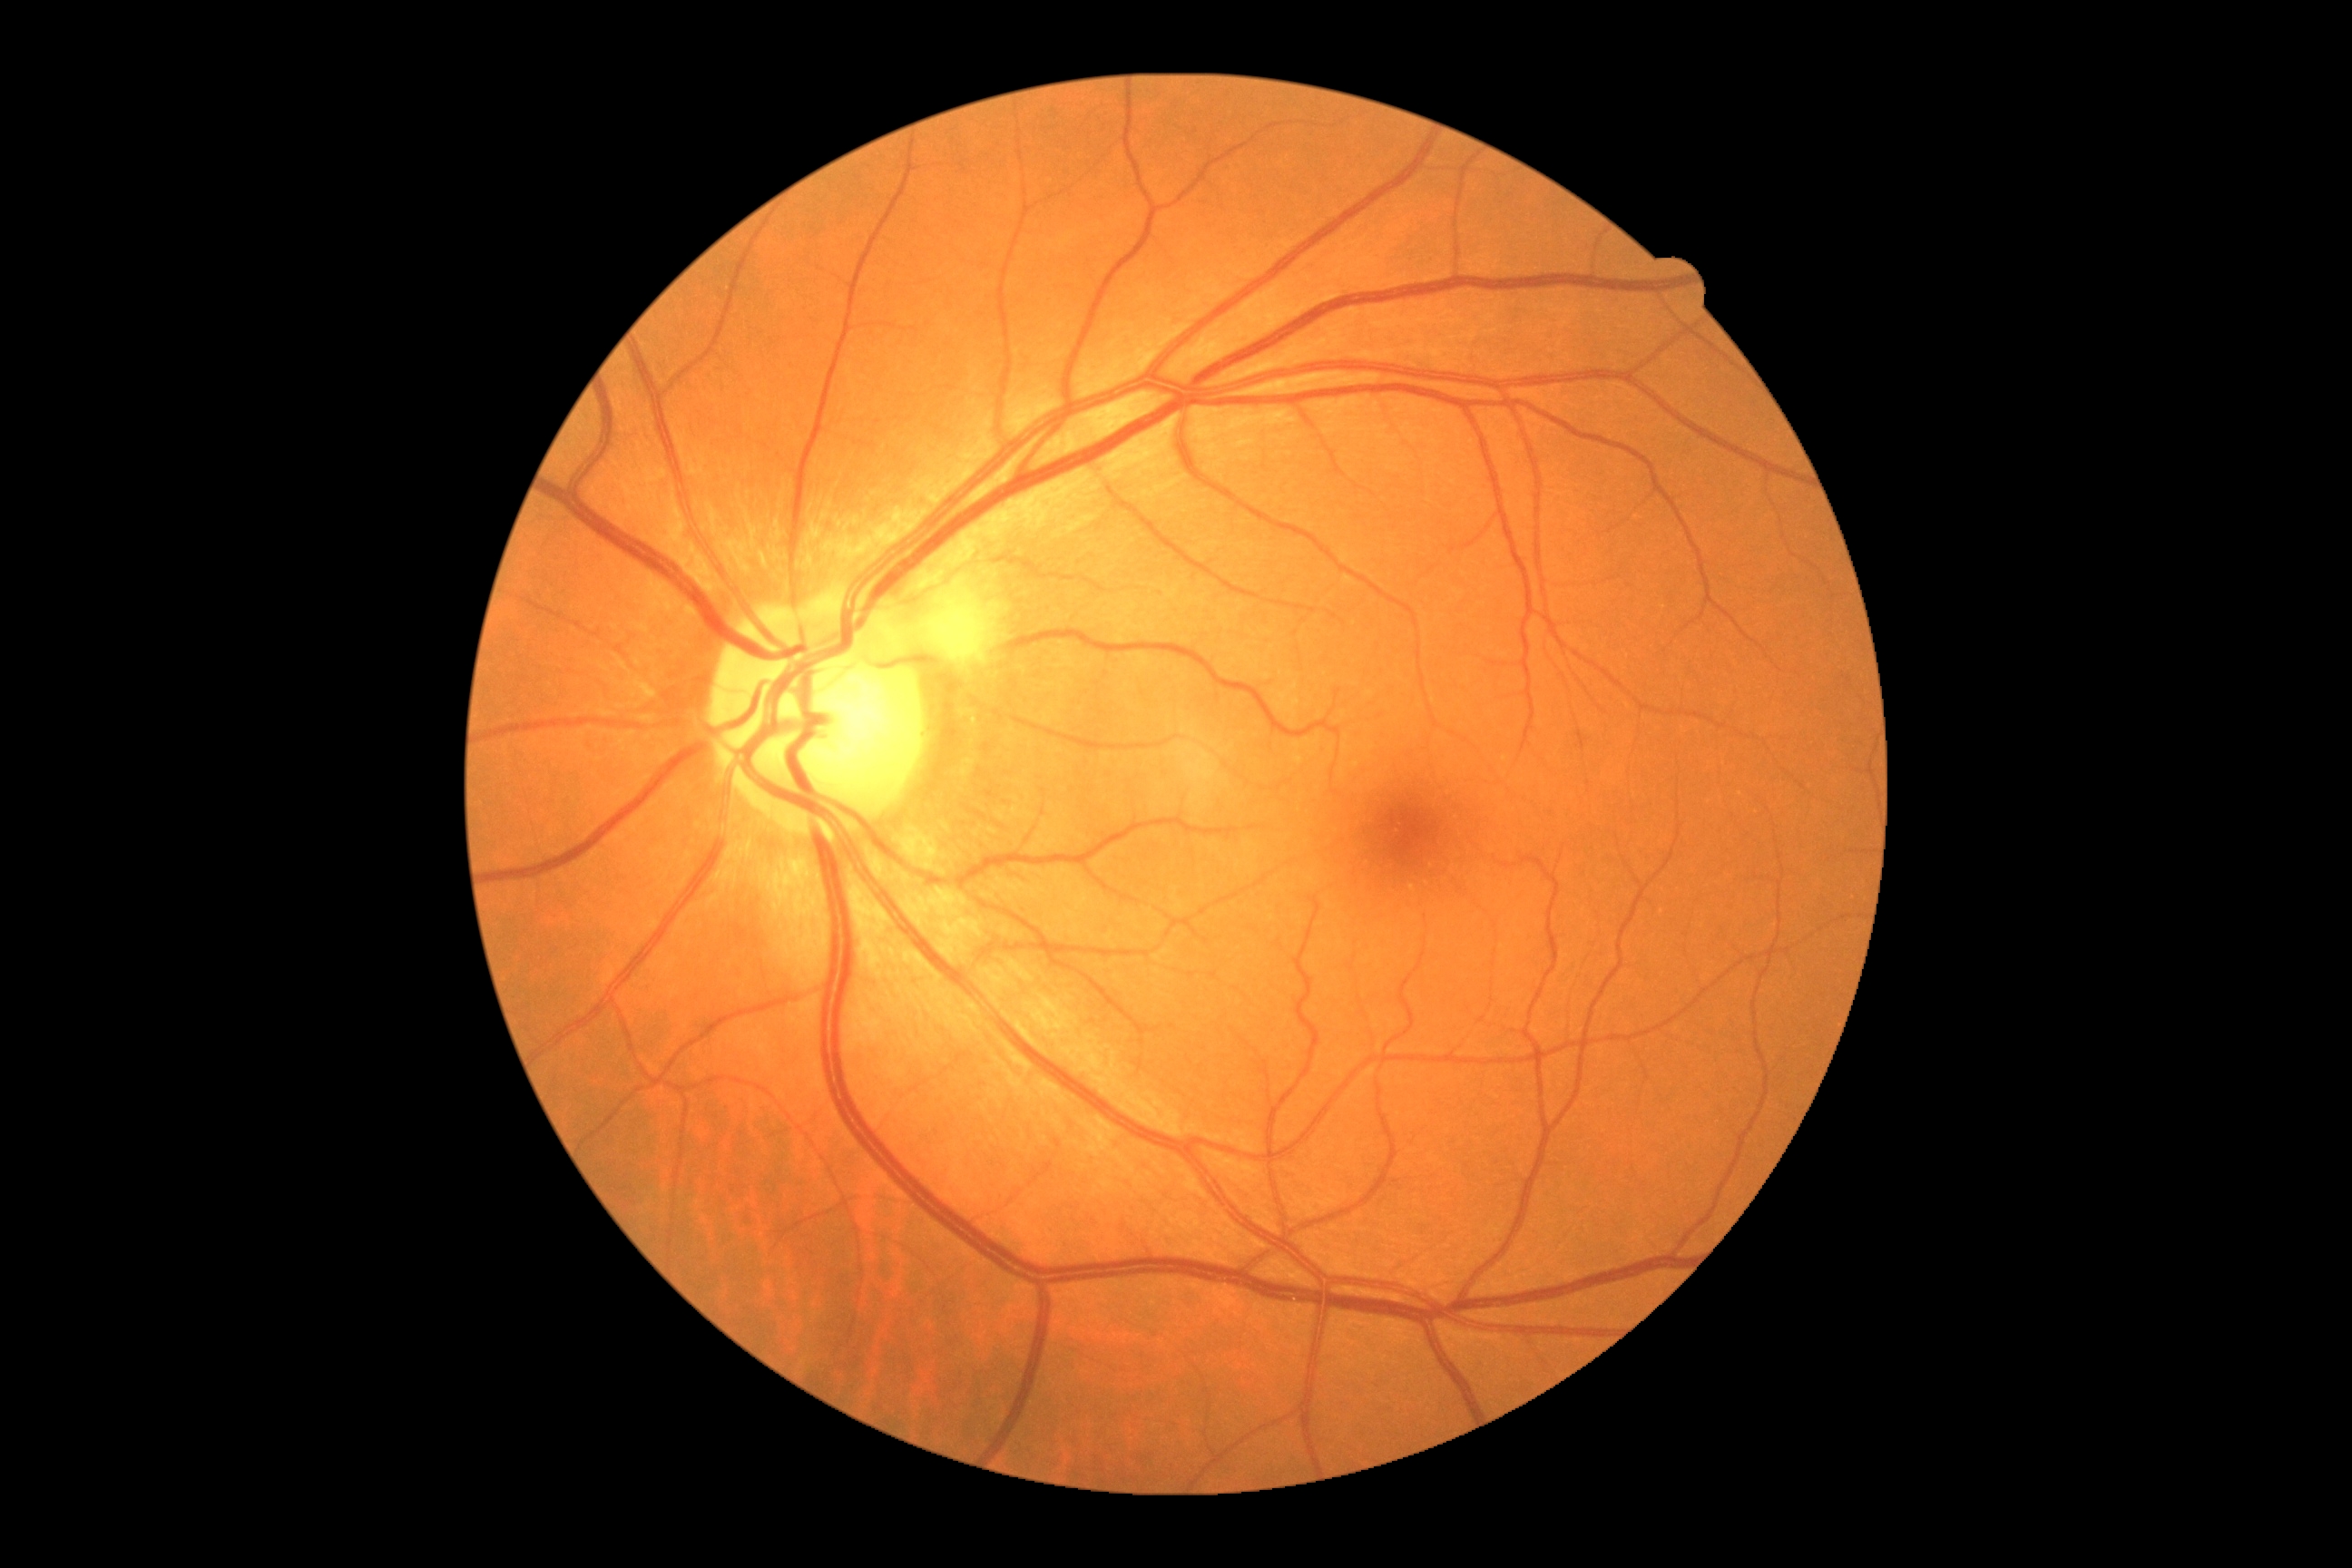
diabetic retinopathy: moderate non-proliferative diabetic retinopathy (grade 2).